Wide-field fundus photograph from neonatal ROP screening. 1240x1240. Phoenix ICON, 100° FOV.
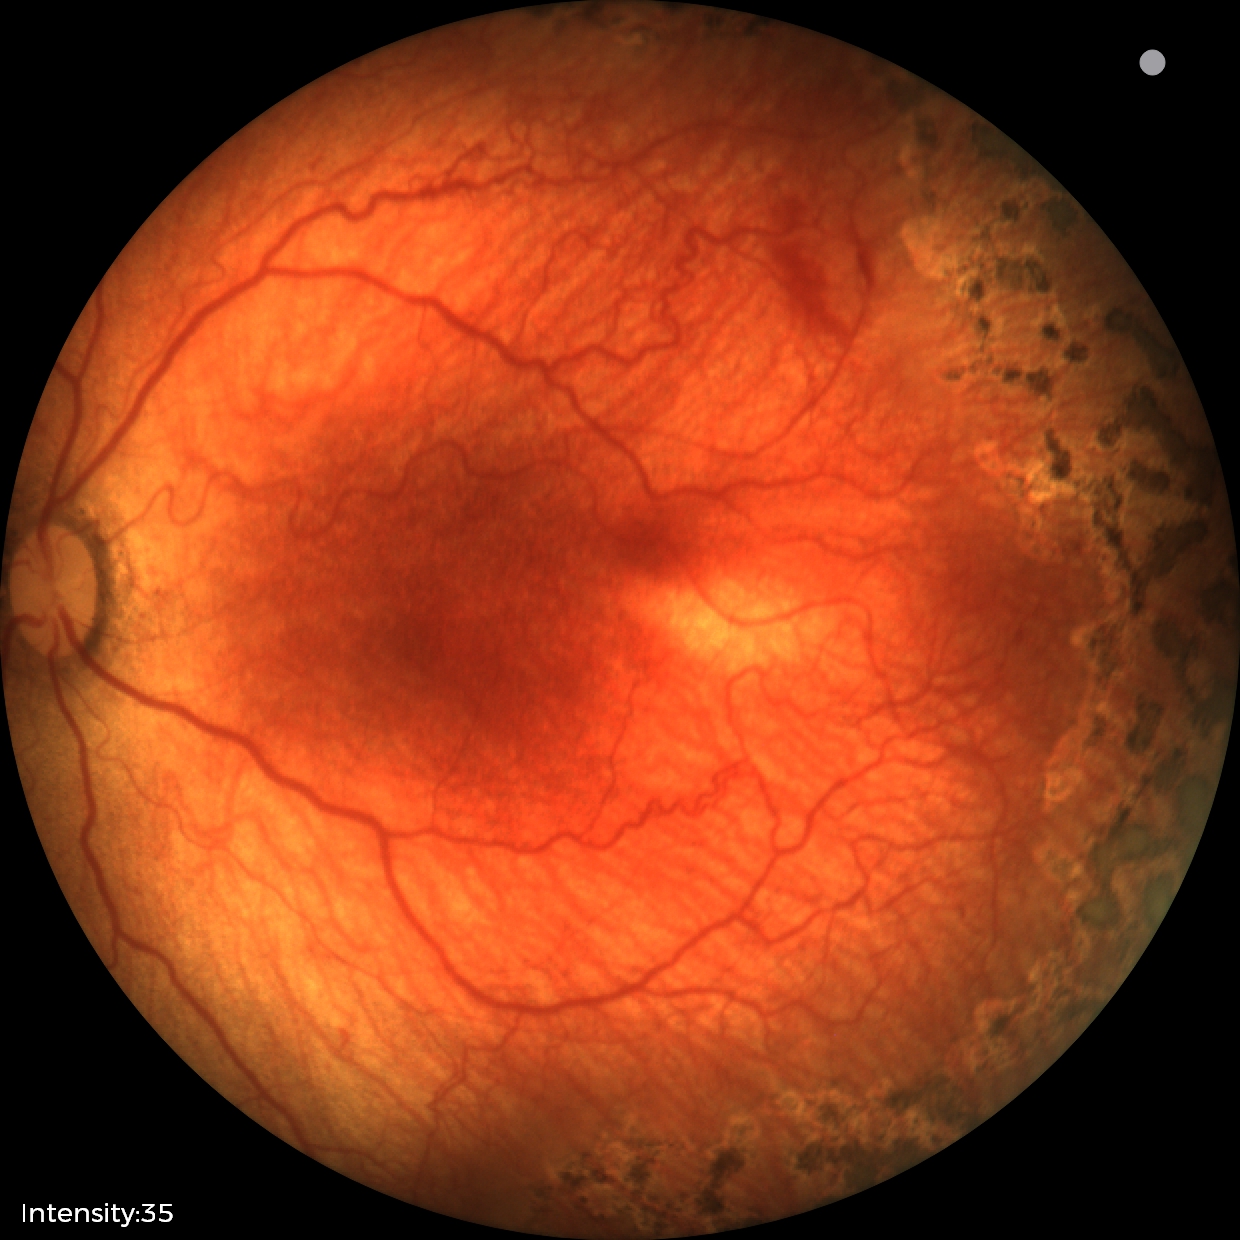
Screening diagnosis: retinopathy of prematurity stage 1 — demarcation line between vascular and avascular retina.